Infant wide-field fundus photograph.
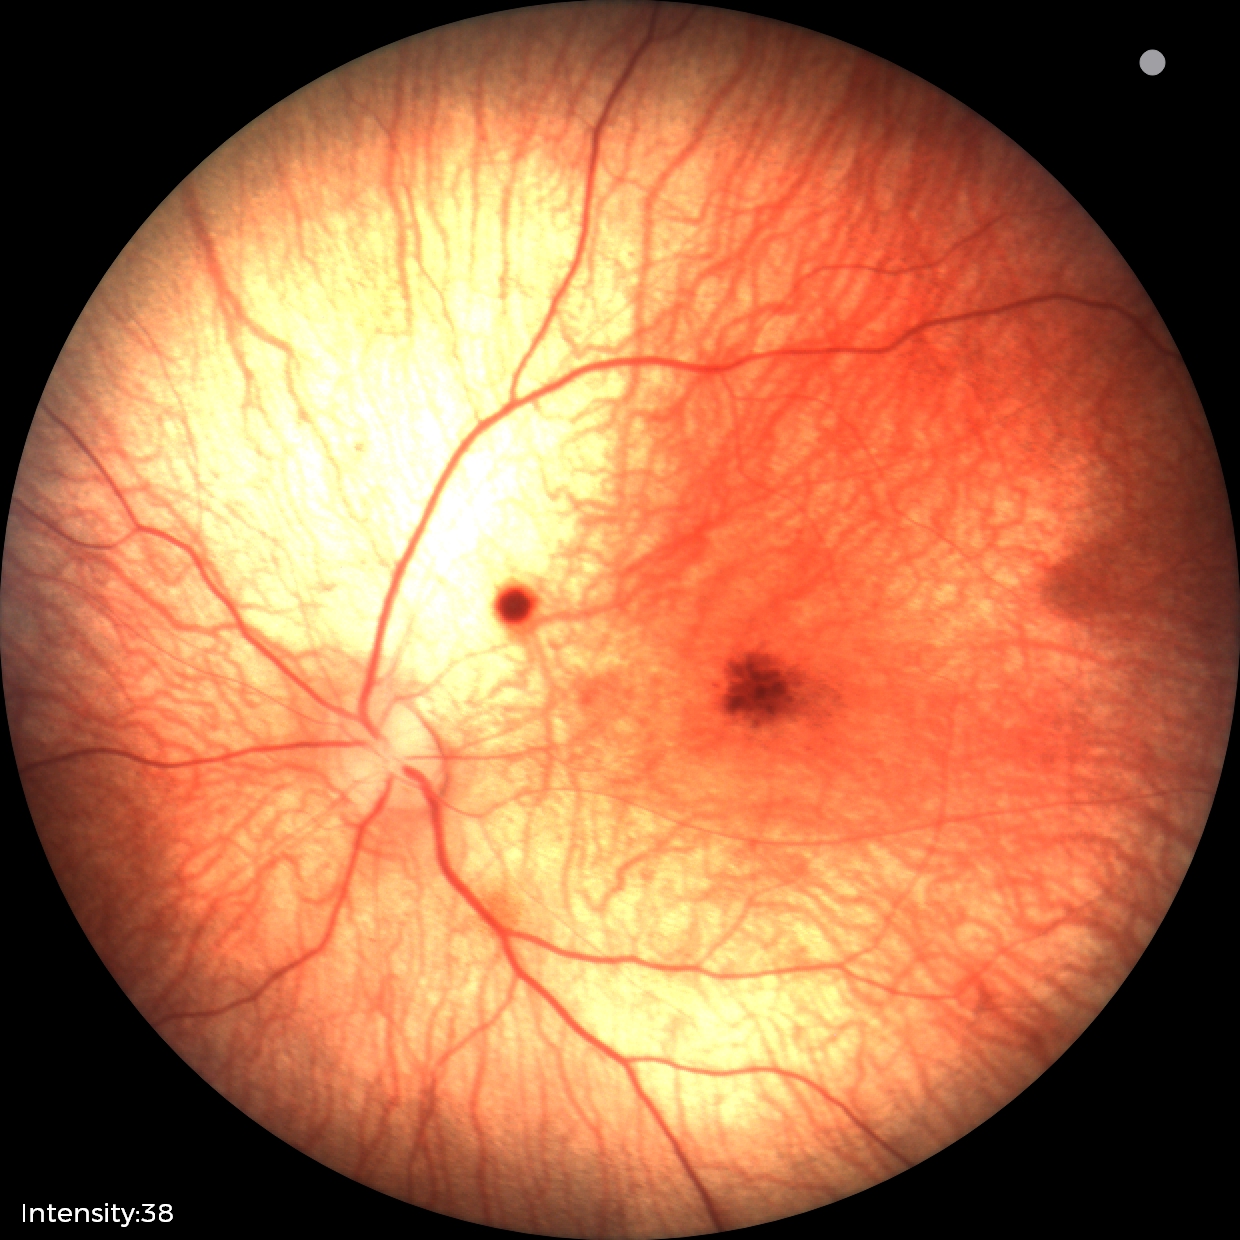 Diagnosis from this screening exam: retinal hemorrhages.